1380 by 1382 pixels · fundus photo — 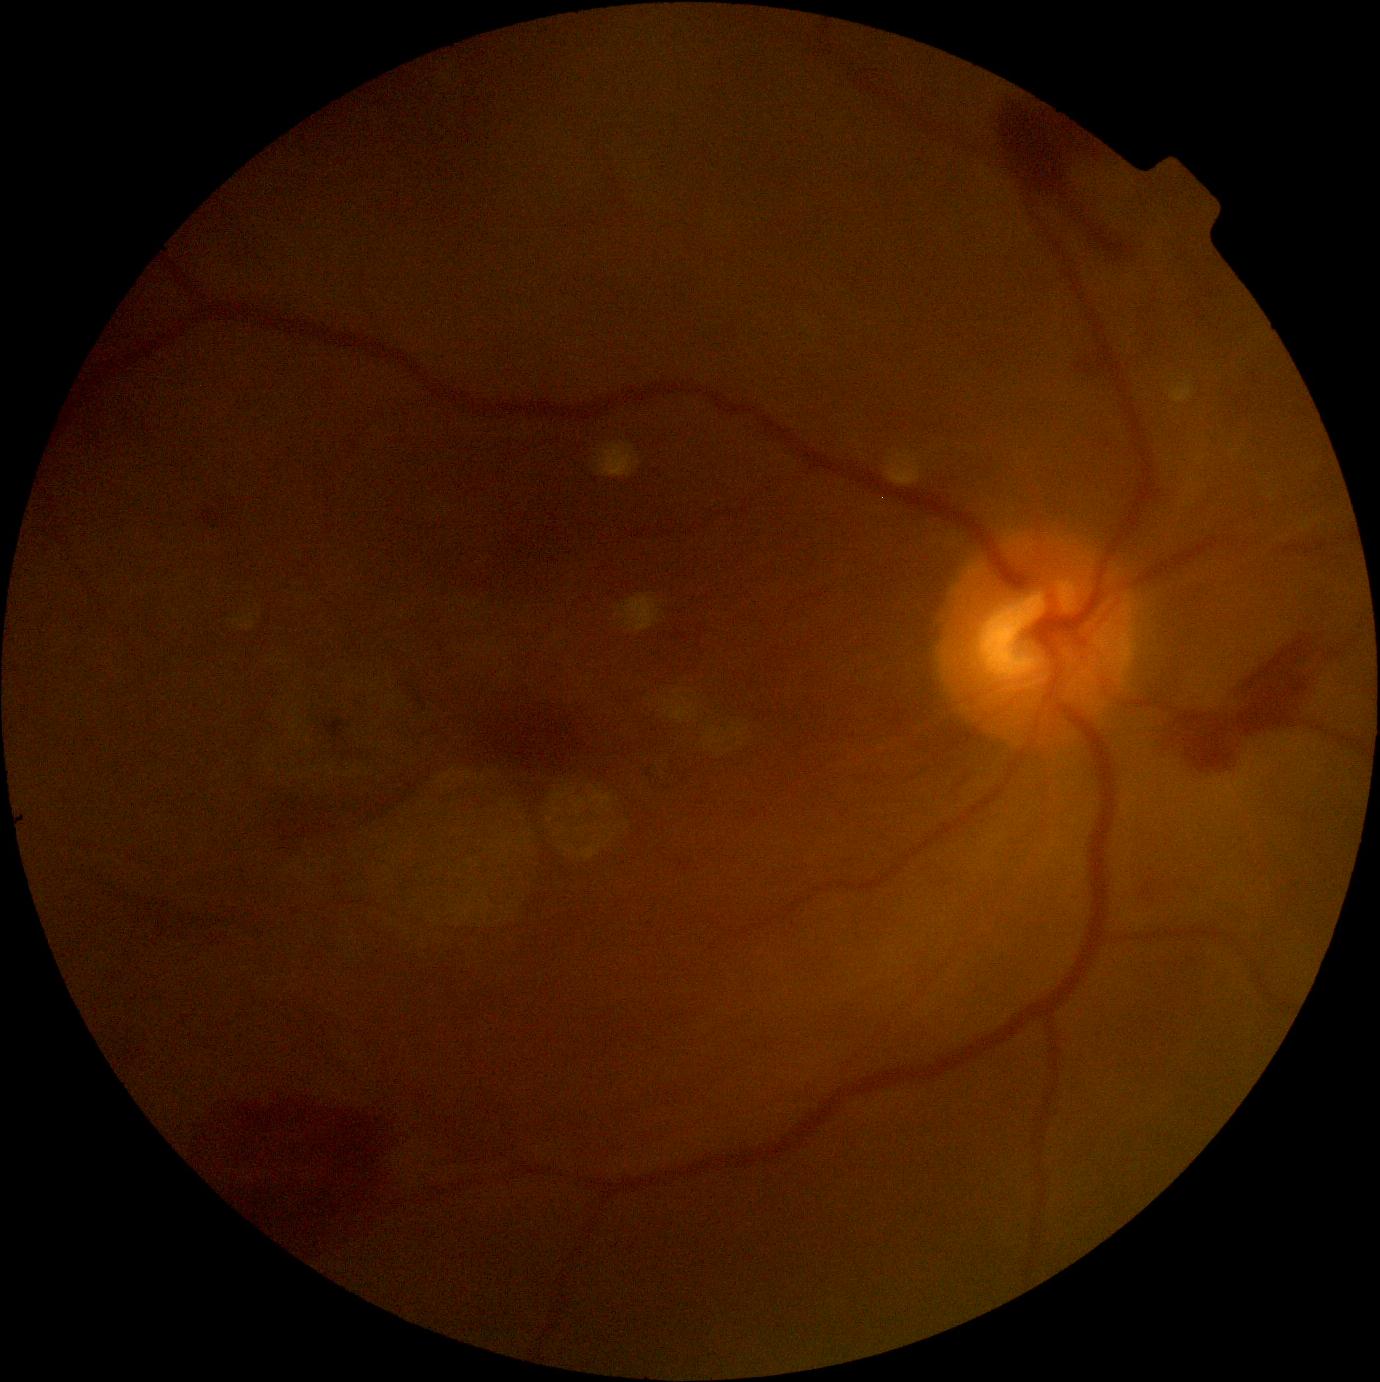

Diabetic retinopathy (DR): proliferative diabetic retinopathy (grade 4) — neovascularization and/or vitreous/pre-retinal hemorrhage.
Disease class: proliferative diabetic retinopathy.